130° field of view (Clarity RetCam 3) · 640 x 480 pixels · infant wide-field fundus photograph.
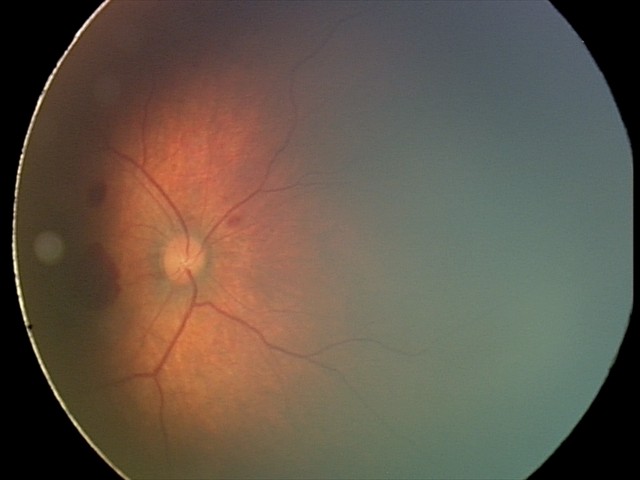
Q: What is the diagnosis from this examination?
A: retinal hemorrhages